45° FOV, color fundus photograph.
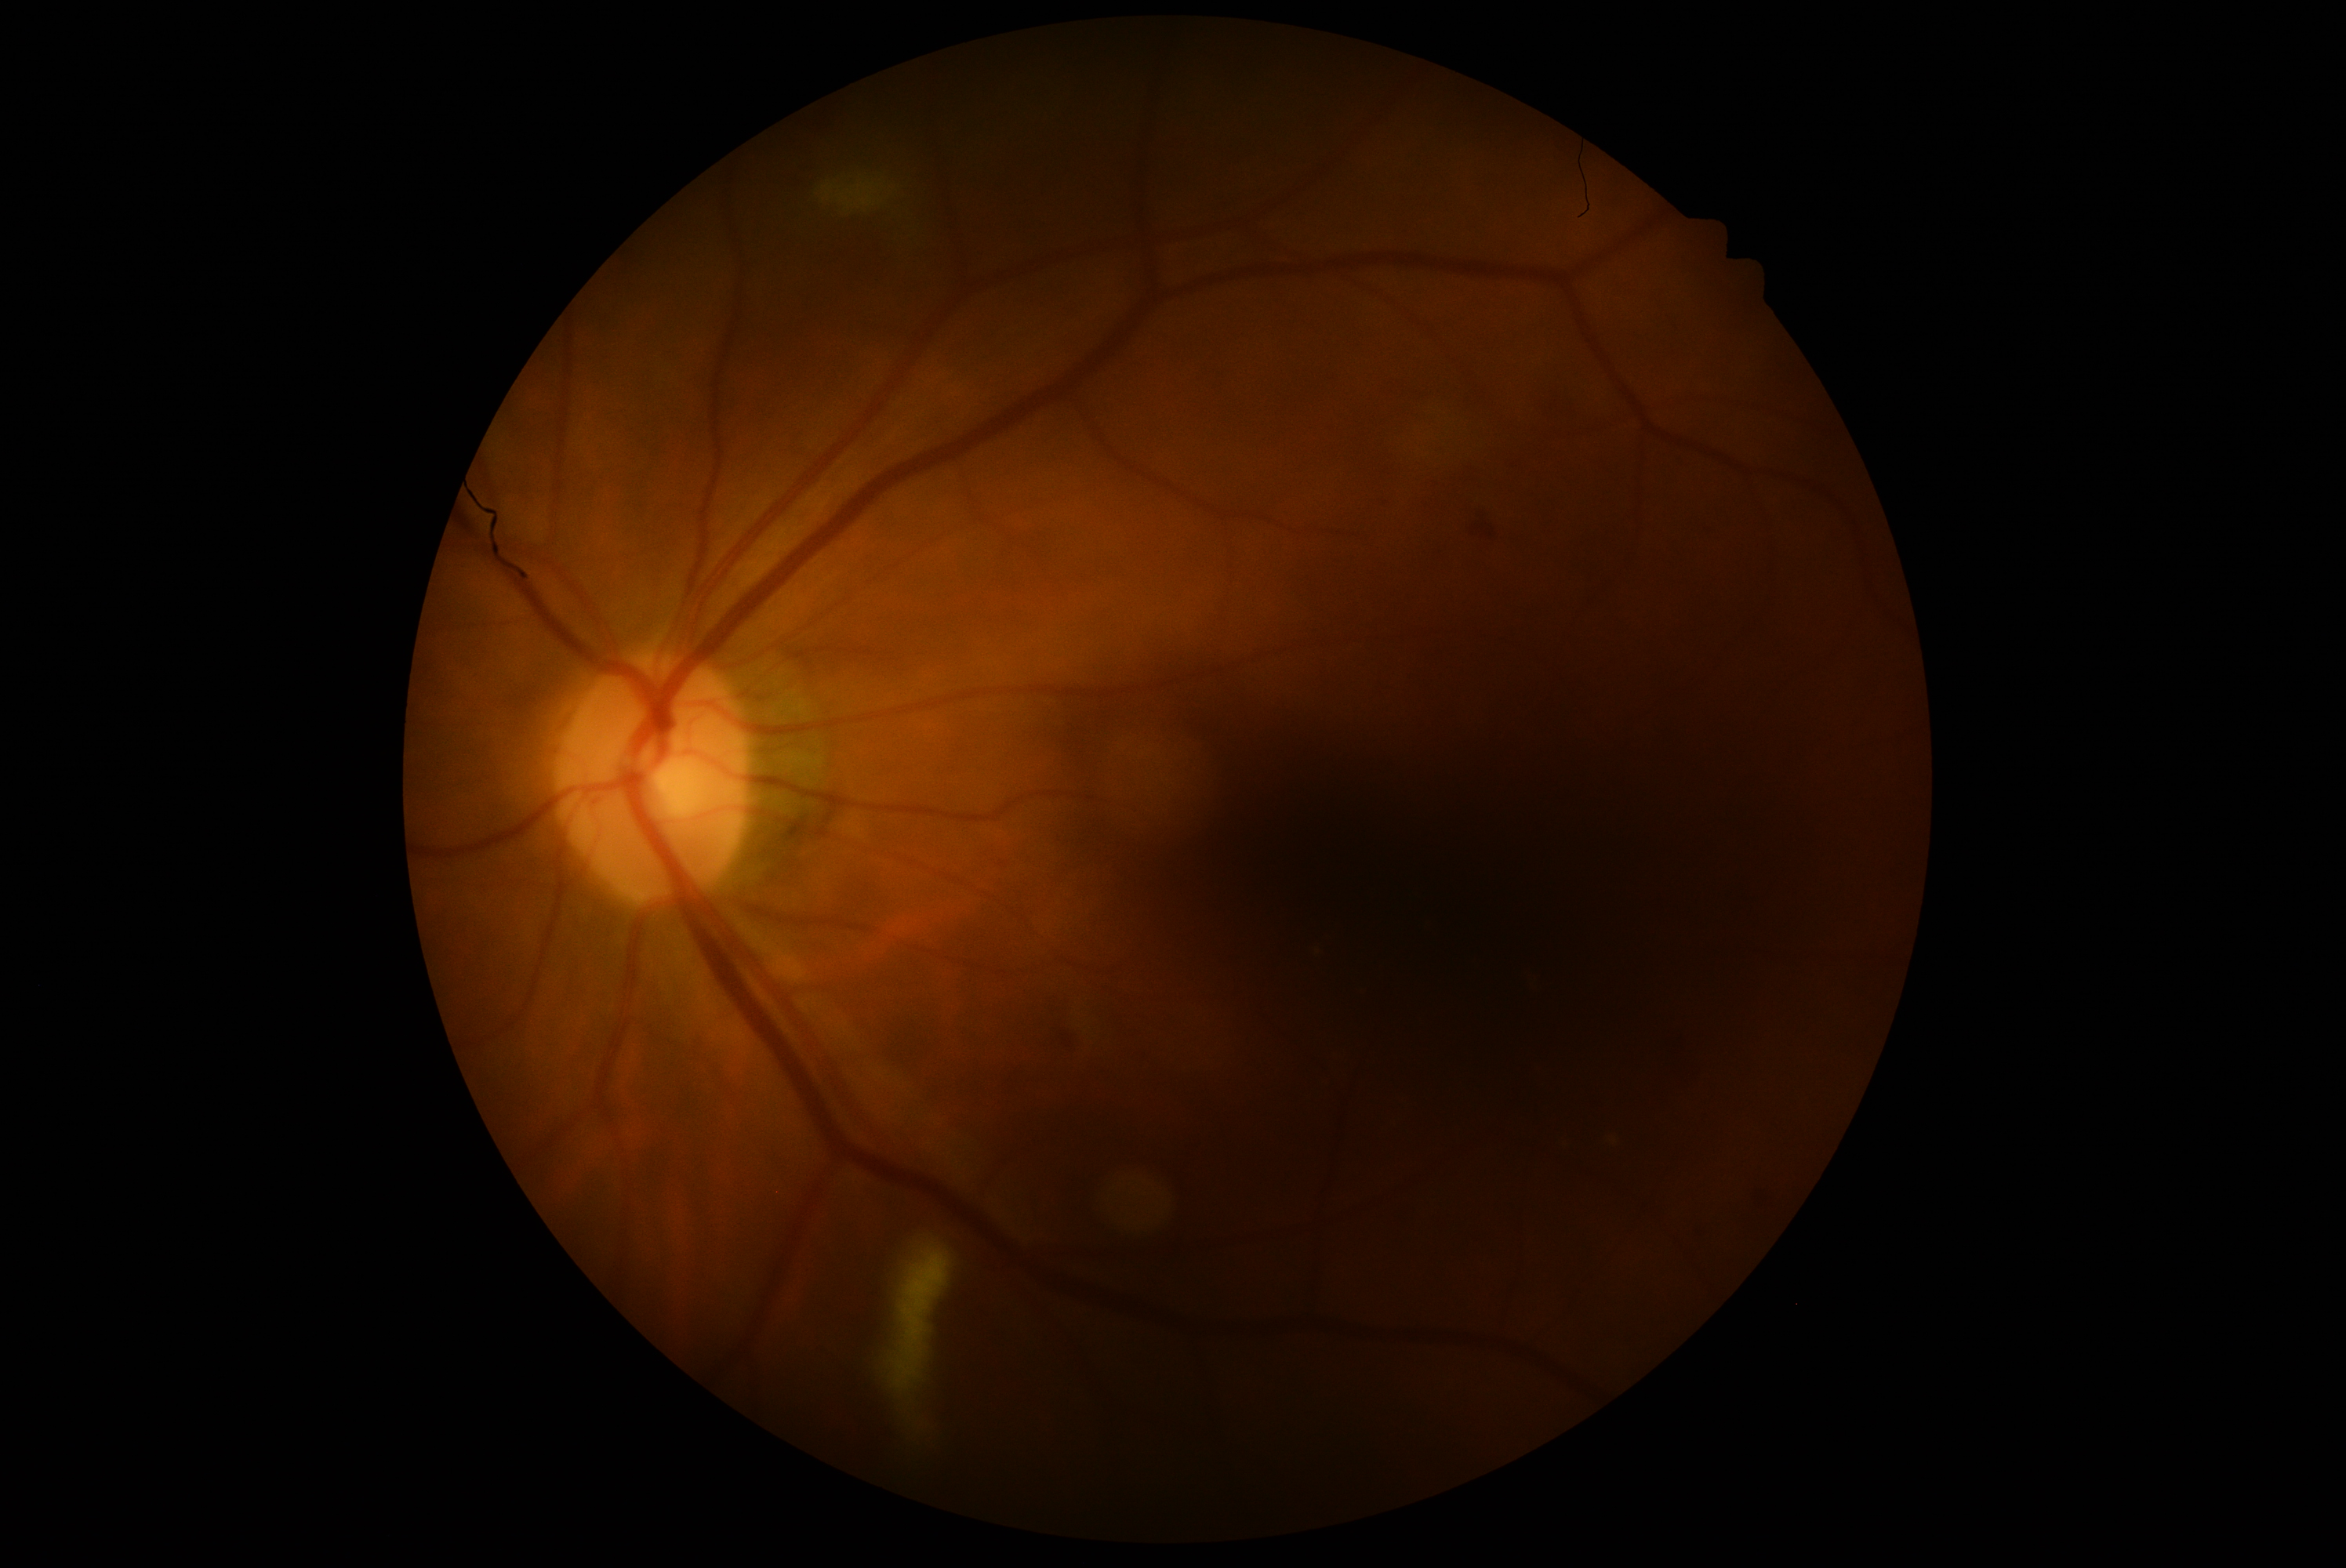
diabetic retinopathy grade@moderate non-proliferative diabetic retinopathy (2).